45-degree field of view, fundus photo, 1932x1916px — 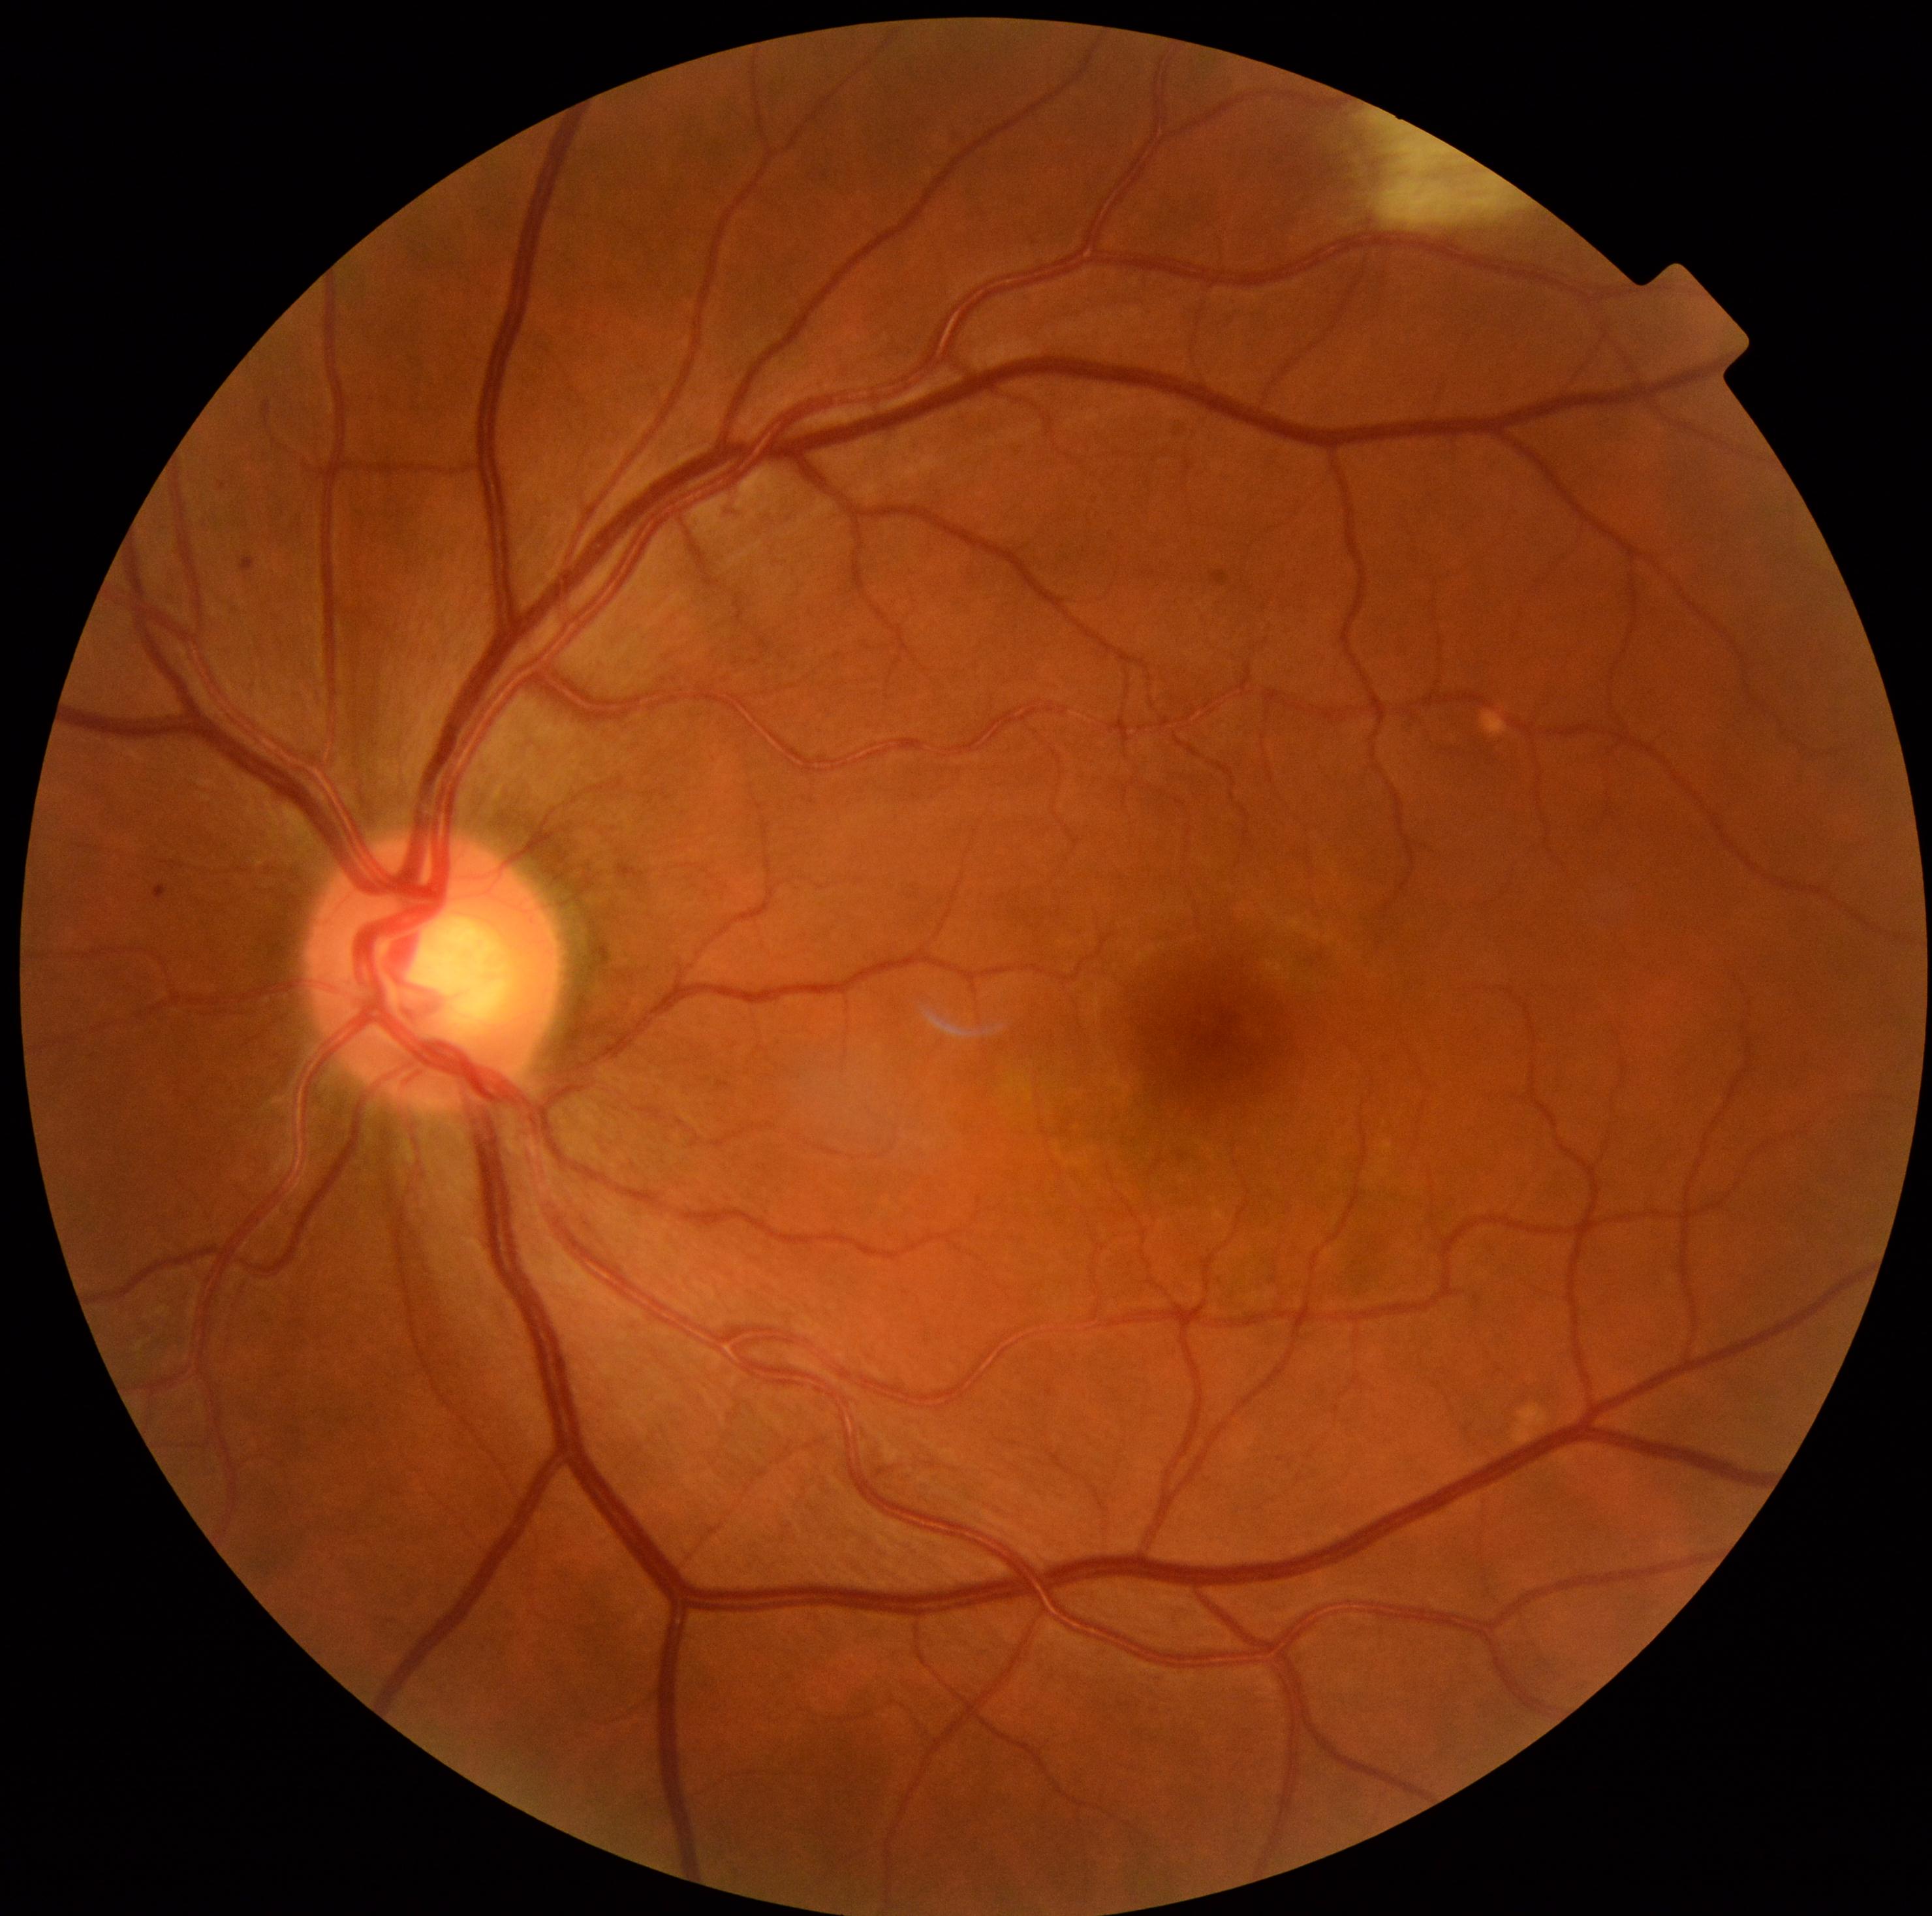 DR: mild non-proliferative diabetic retinopathy (grade 1).